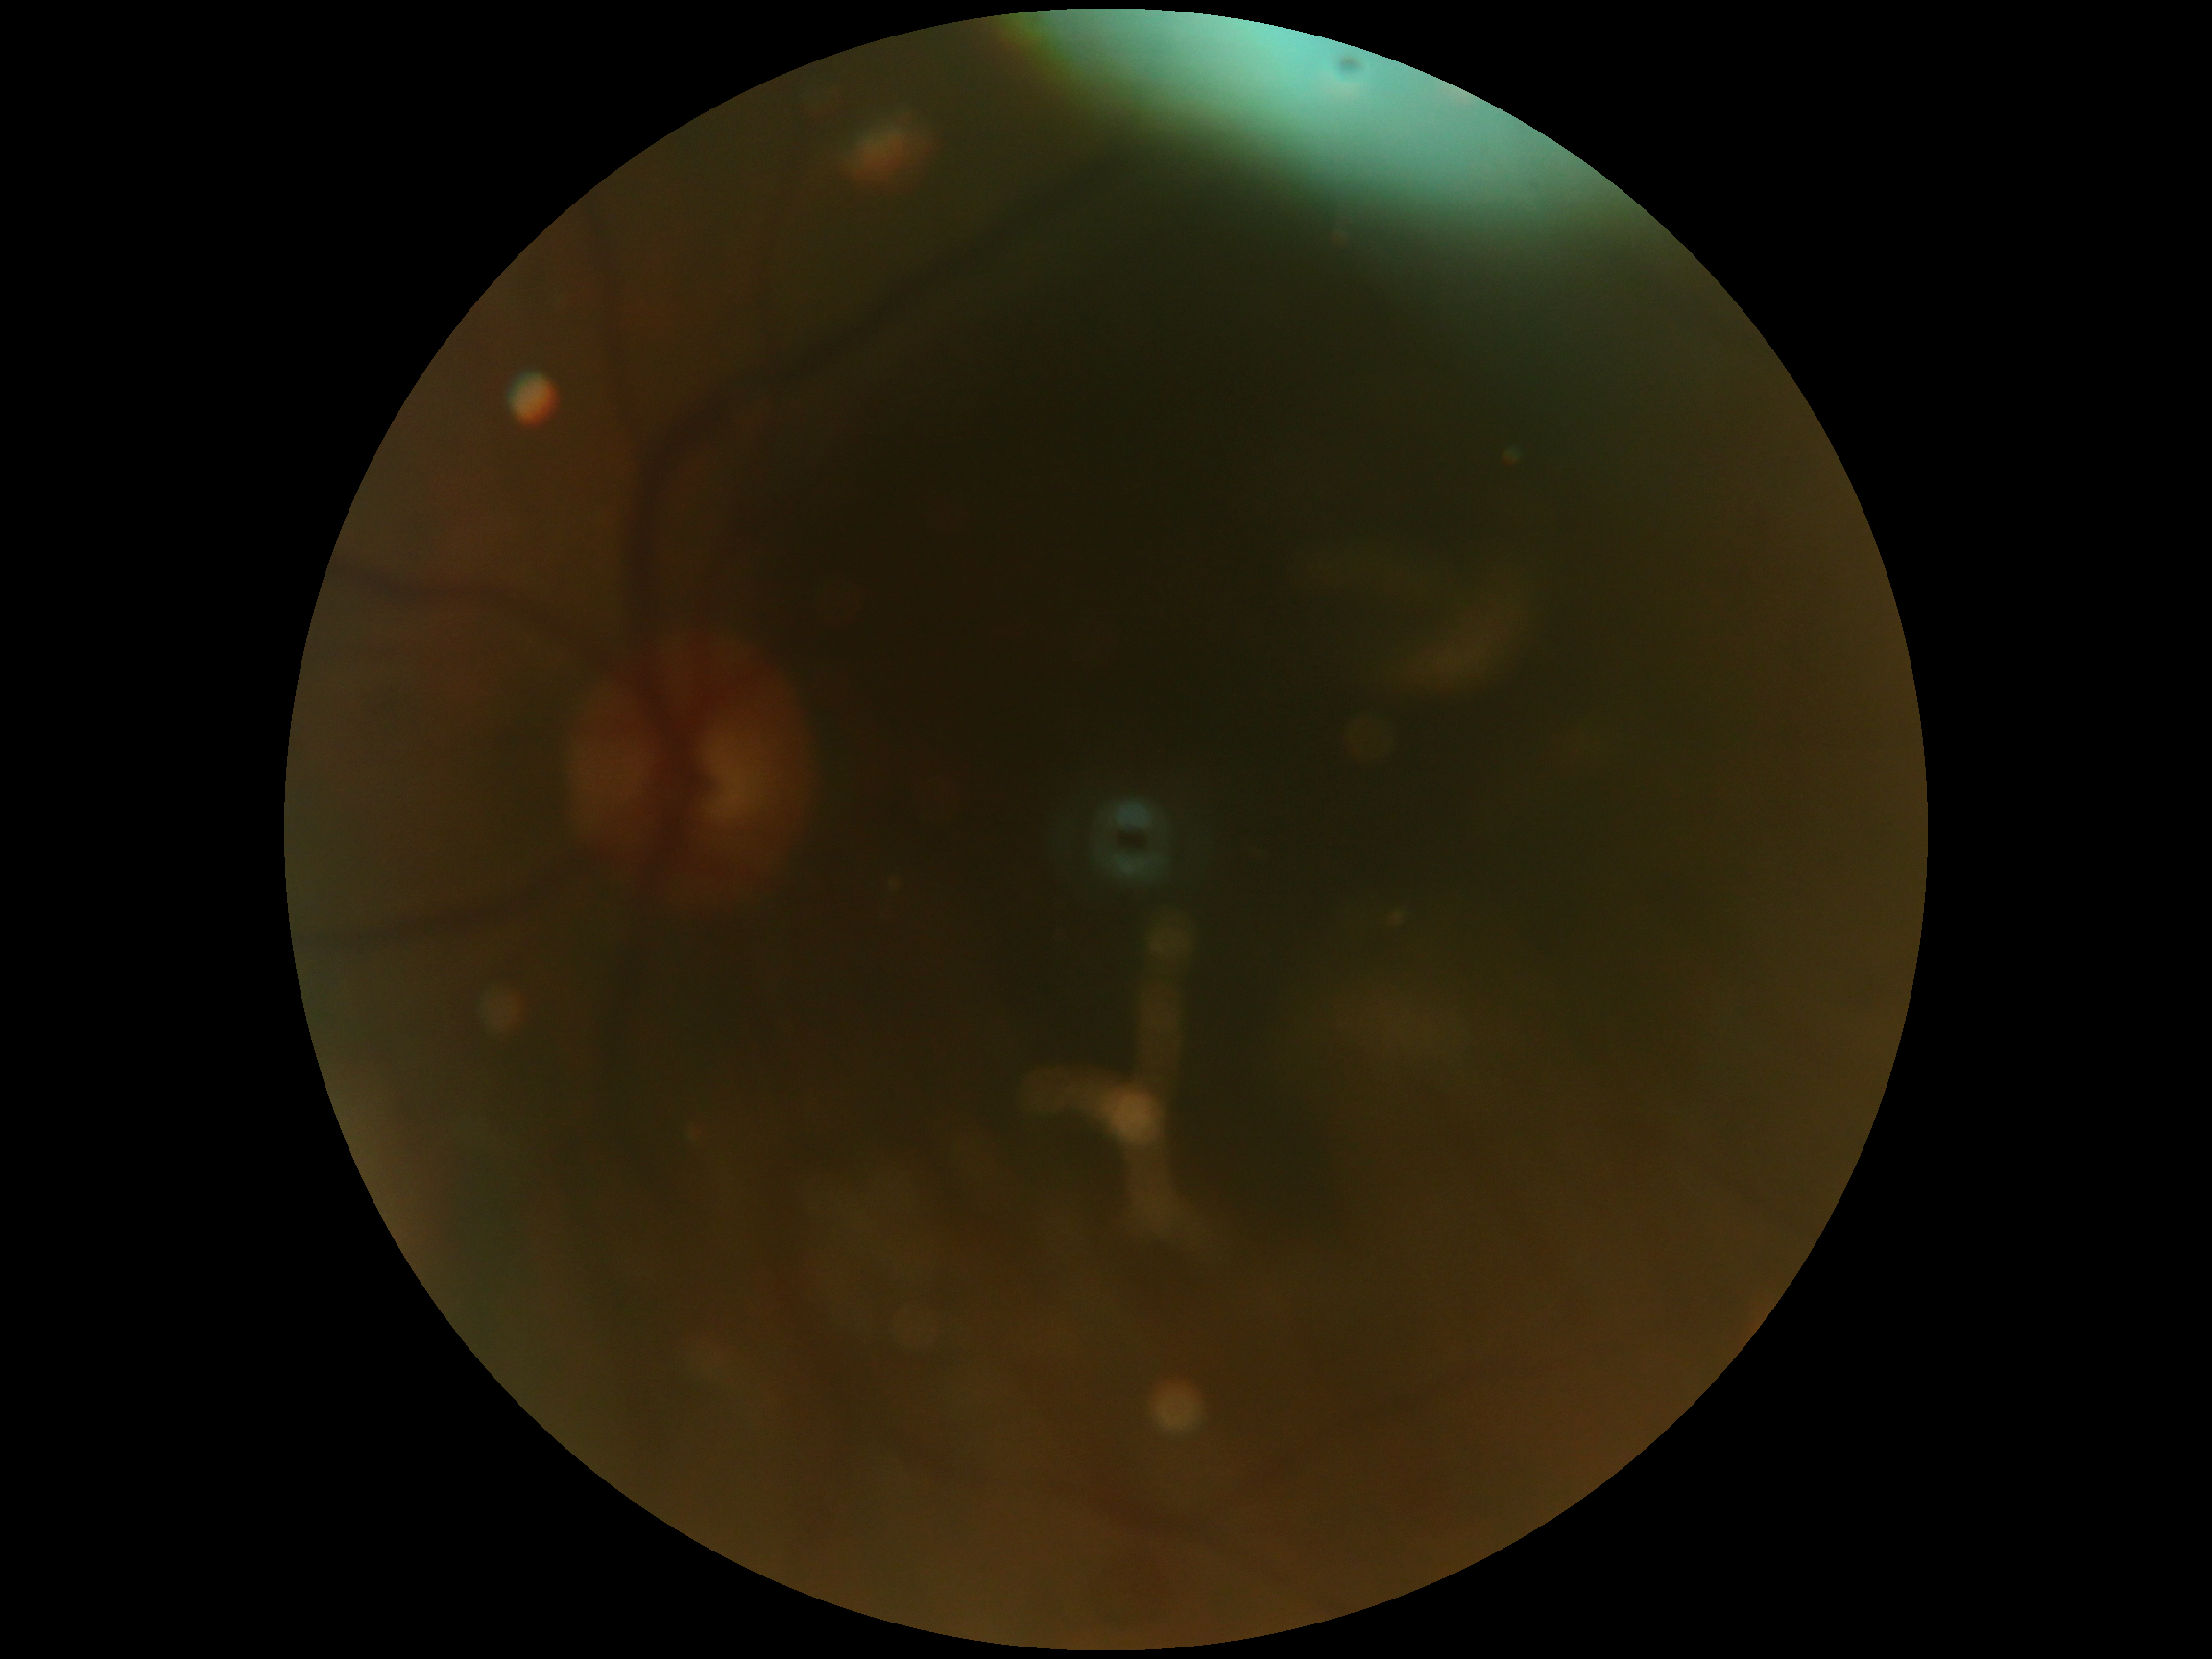
image quality = below grading threshold
diabetic retinopathy (DR) = ungradable